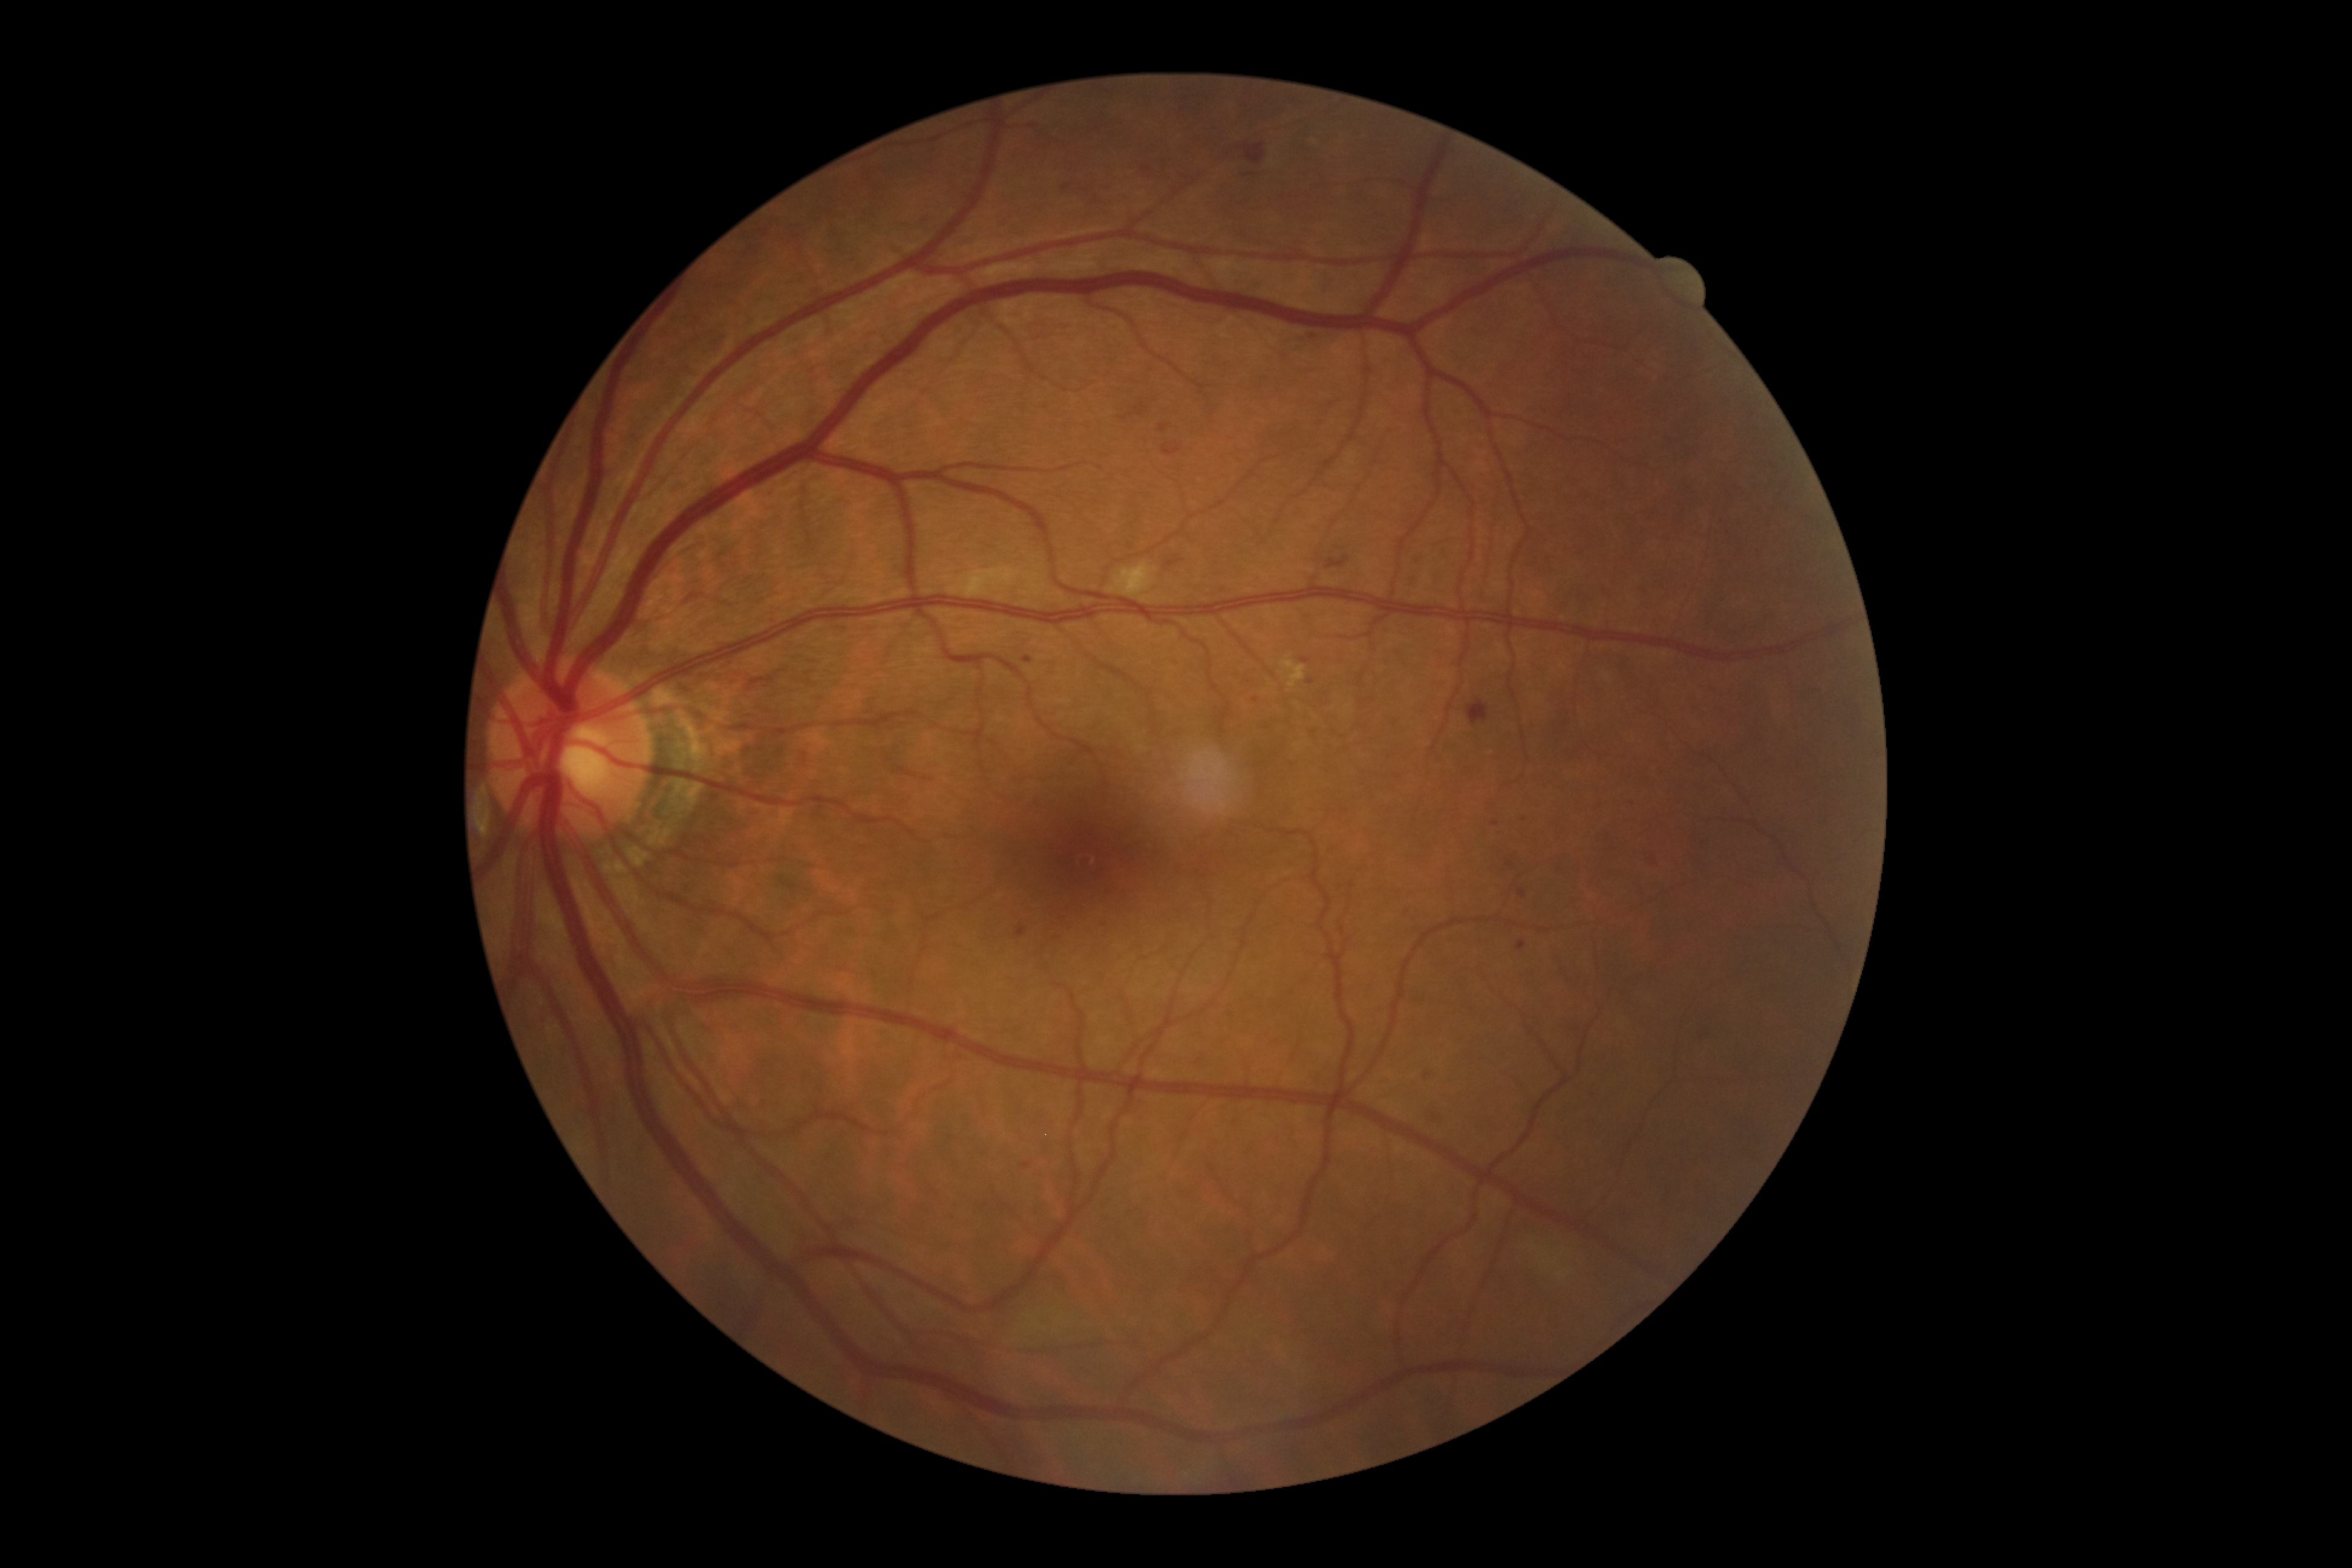
Diabetic retinopathy (DR): grade 2; non-proliferative diabetic retinopathy
Representative lesions:
soft exudates (SEs) (partial): (1513,1238,1565,1273), (1109,561,1157,596), (949,567,1023,597)
microaneurysms (MAs) (partial): (1302,658,1310,665), (1022,656,1034,665), (1305,678,1316,685), (1517,941,1526,949), (1491,820,1500,827), (1160,424,1171,434), (1021,1162,1031,1169), (1093,919,1104,924), (1063,185,1071,191), (1165,445,1173,454), (1519,890,1527,898)
MAs (small, approximate centers) near <pt>1655,864</pt>, <pt>1313,337</pt>, <pt>1524,819</pt>, <pt>1510,864</pt>, <pt>1256,700</pt>
hard exudates (EXs): (1279,655,1307,688)
hemorrhages (HEs): (1466,699,1489,725), (1167,556,1185,568), (1241,145,1266,165), (1059,177,1077,192), (1327,556,1350,569), (1195,1054,1204,1067), (1134,402,1146,417), (1696,1025,1705,1039), (1140,168,1149,174), (1426,1112,1438,1122), (1425,1070,1433,1080), (1313,419,1325,426), (1240,172,1260,177), (1651,855,1659,868), (1411,577,1417,589), (1162,445,1181,456), (1017,926,1028,938), (1417,551,1427,563)